NIDEK AFC-230 fundus camera, 848 x 848 pixels, modified Davis grading, nonmydriatic, retinal fundus photograph, FOV: 45 degrees:
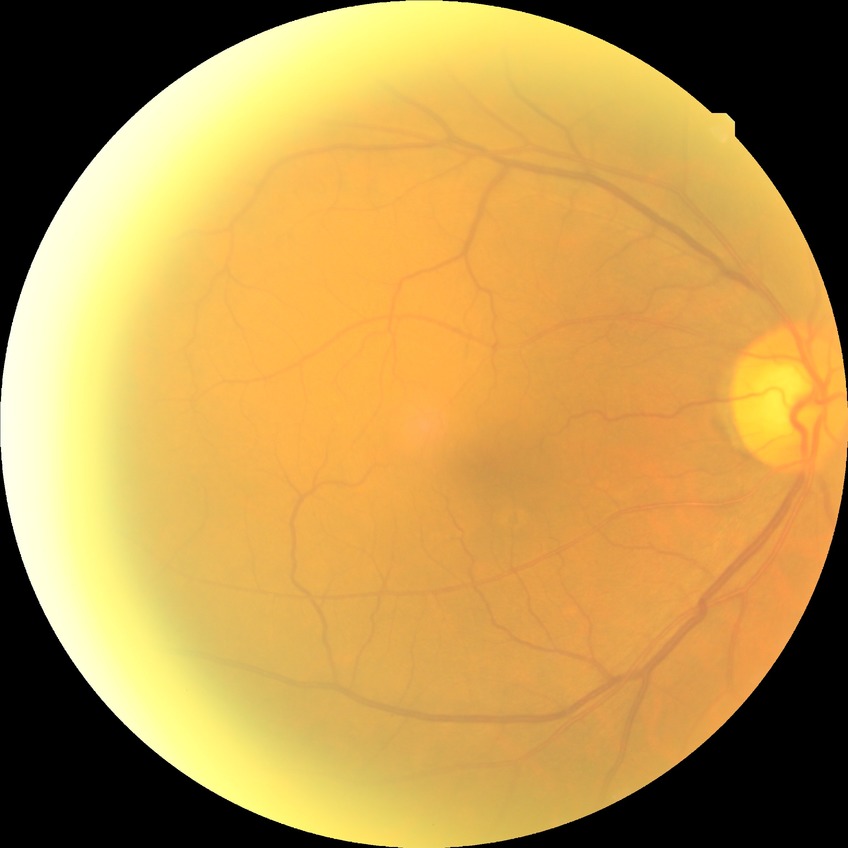   davis_grade: no diabetic retinopathy